No pharmacologic dilation · camera: NIDEK AFC-230 · image size 848x848
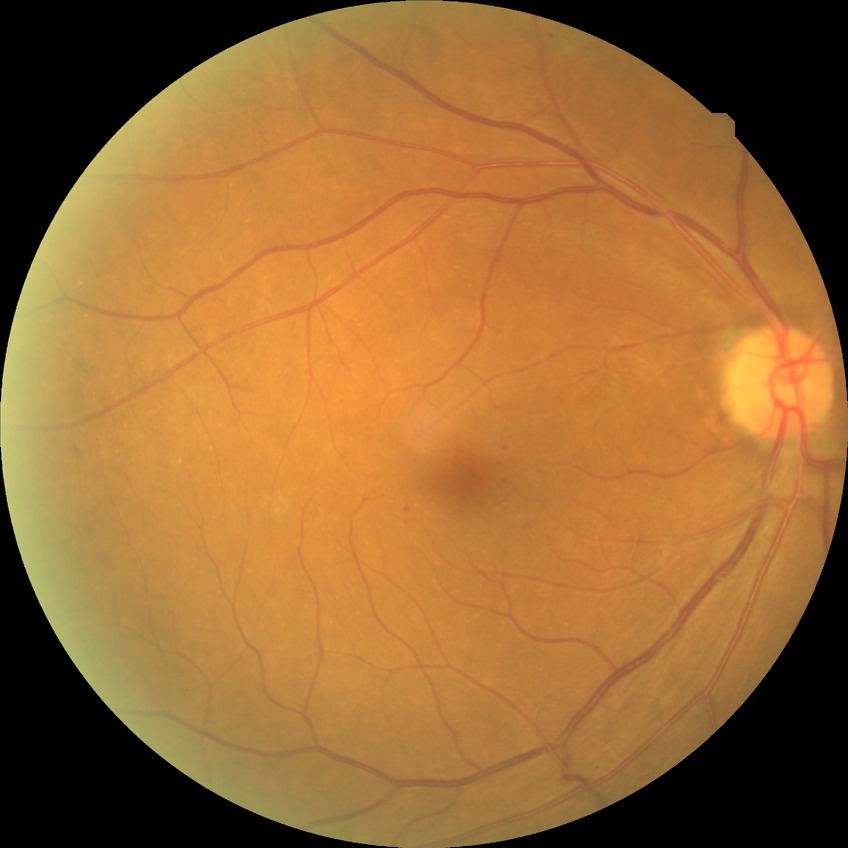

• diabetic retinopathy (DR) — simple diabetic retinopathy (SDR)